Image size 1440x1080. Wide-field fundus image from infant ROP screening — 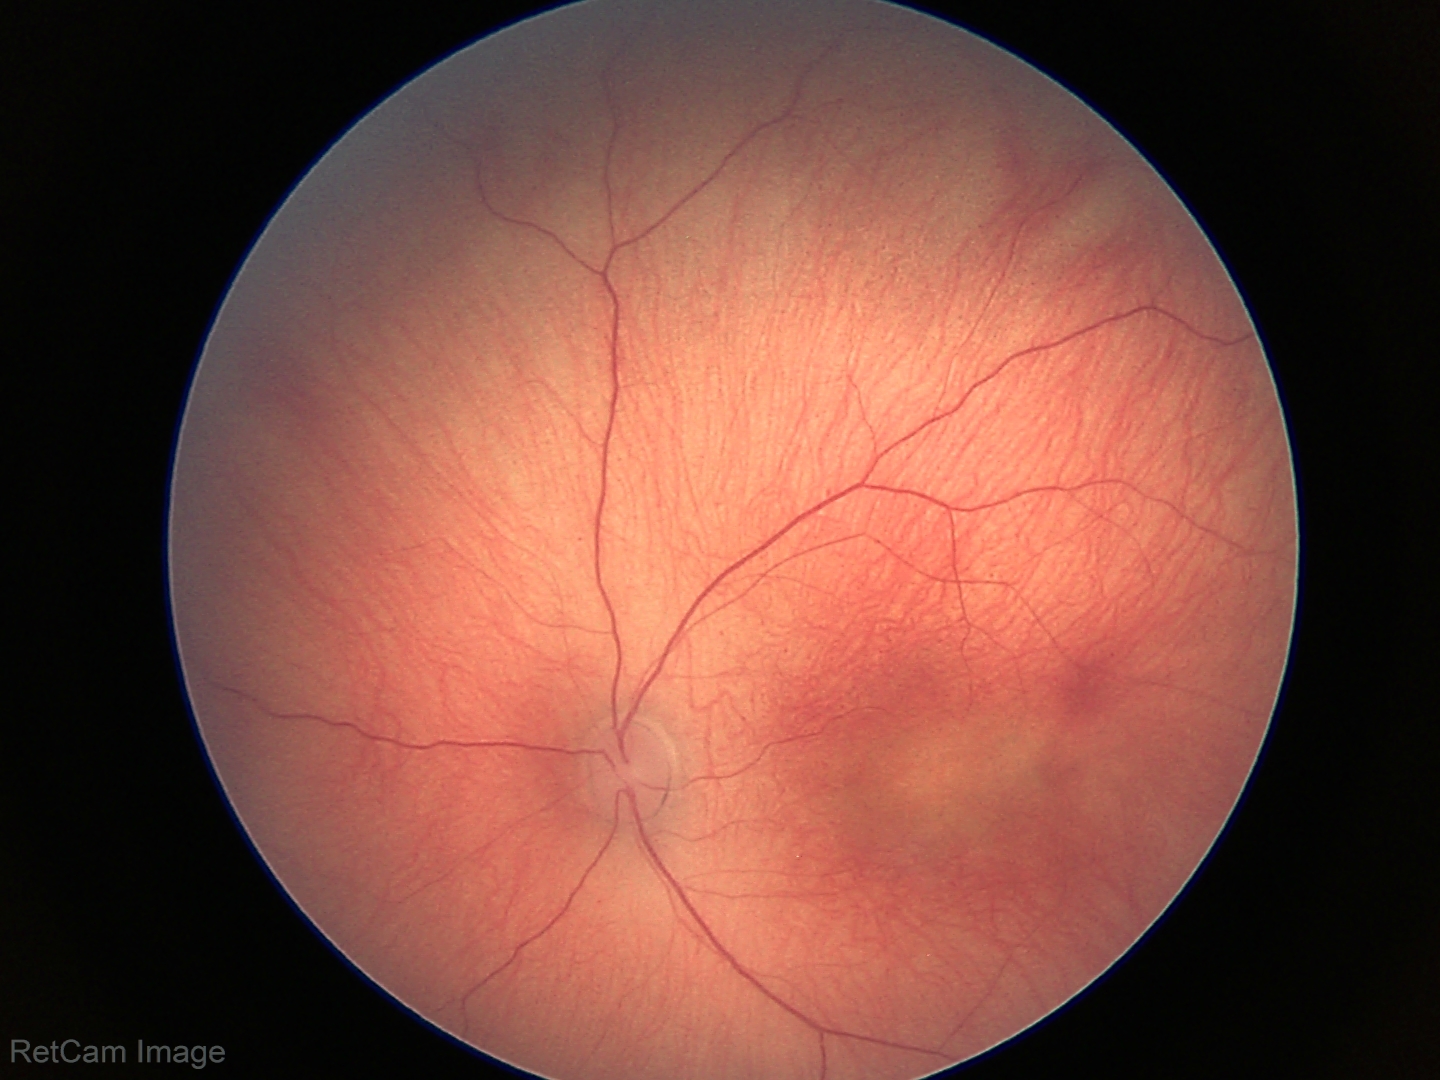
Without plus disease. Screening series with status post ROP.